NIDEK AFC-230; 45° FOV.
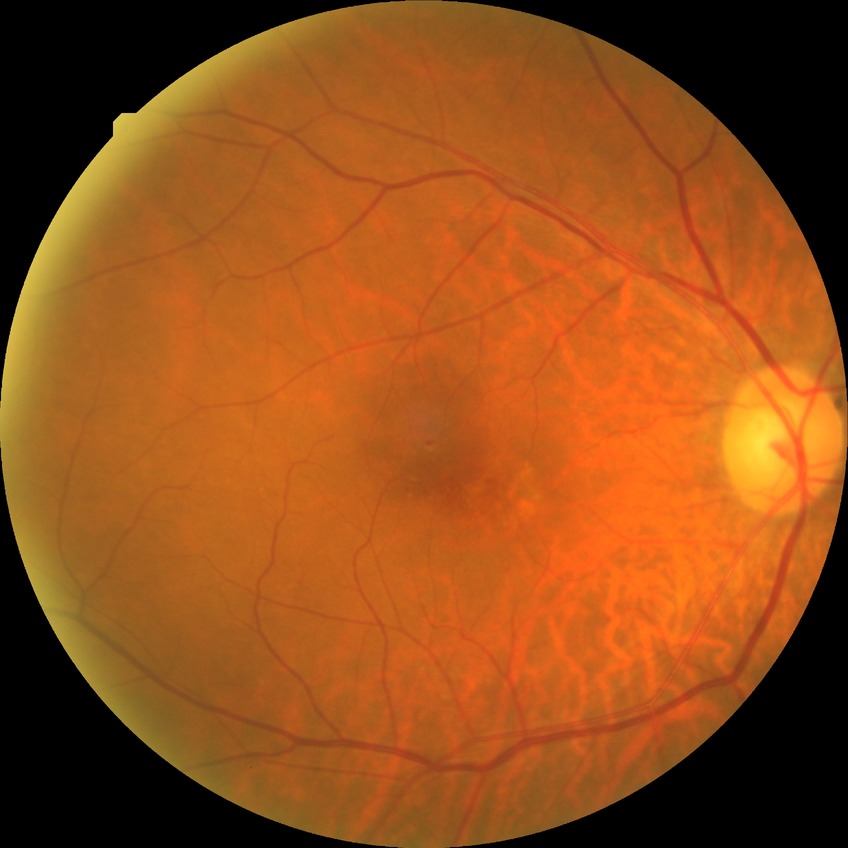
Diabetic retinopathy severity: simple diabetic retinopathy.